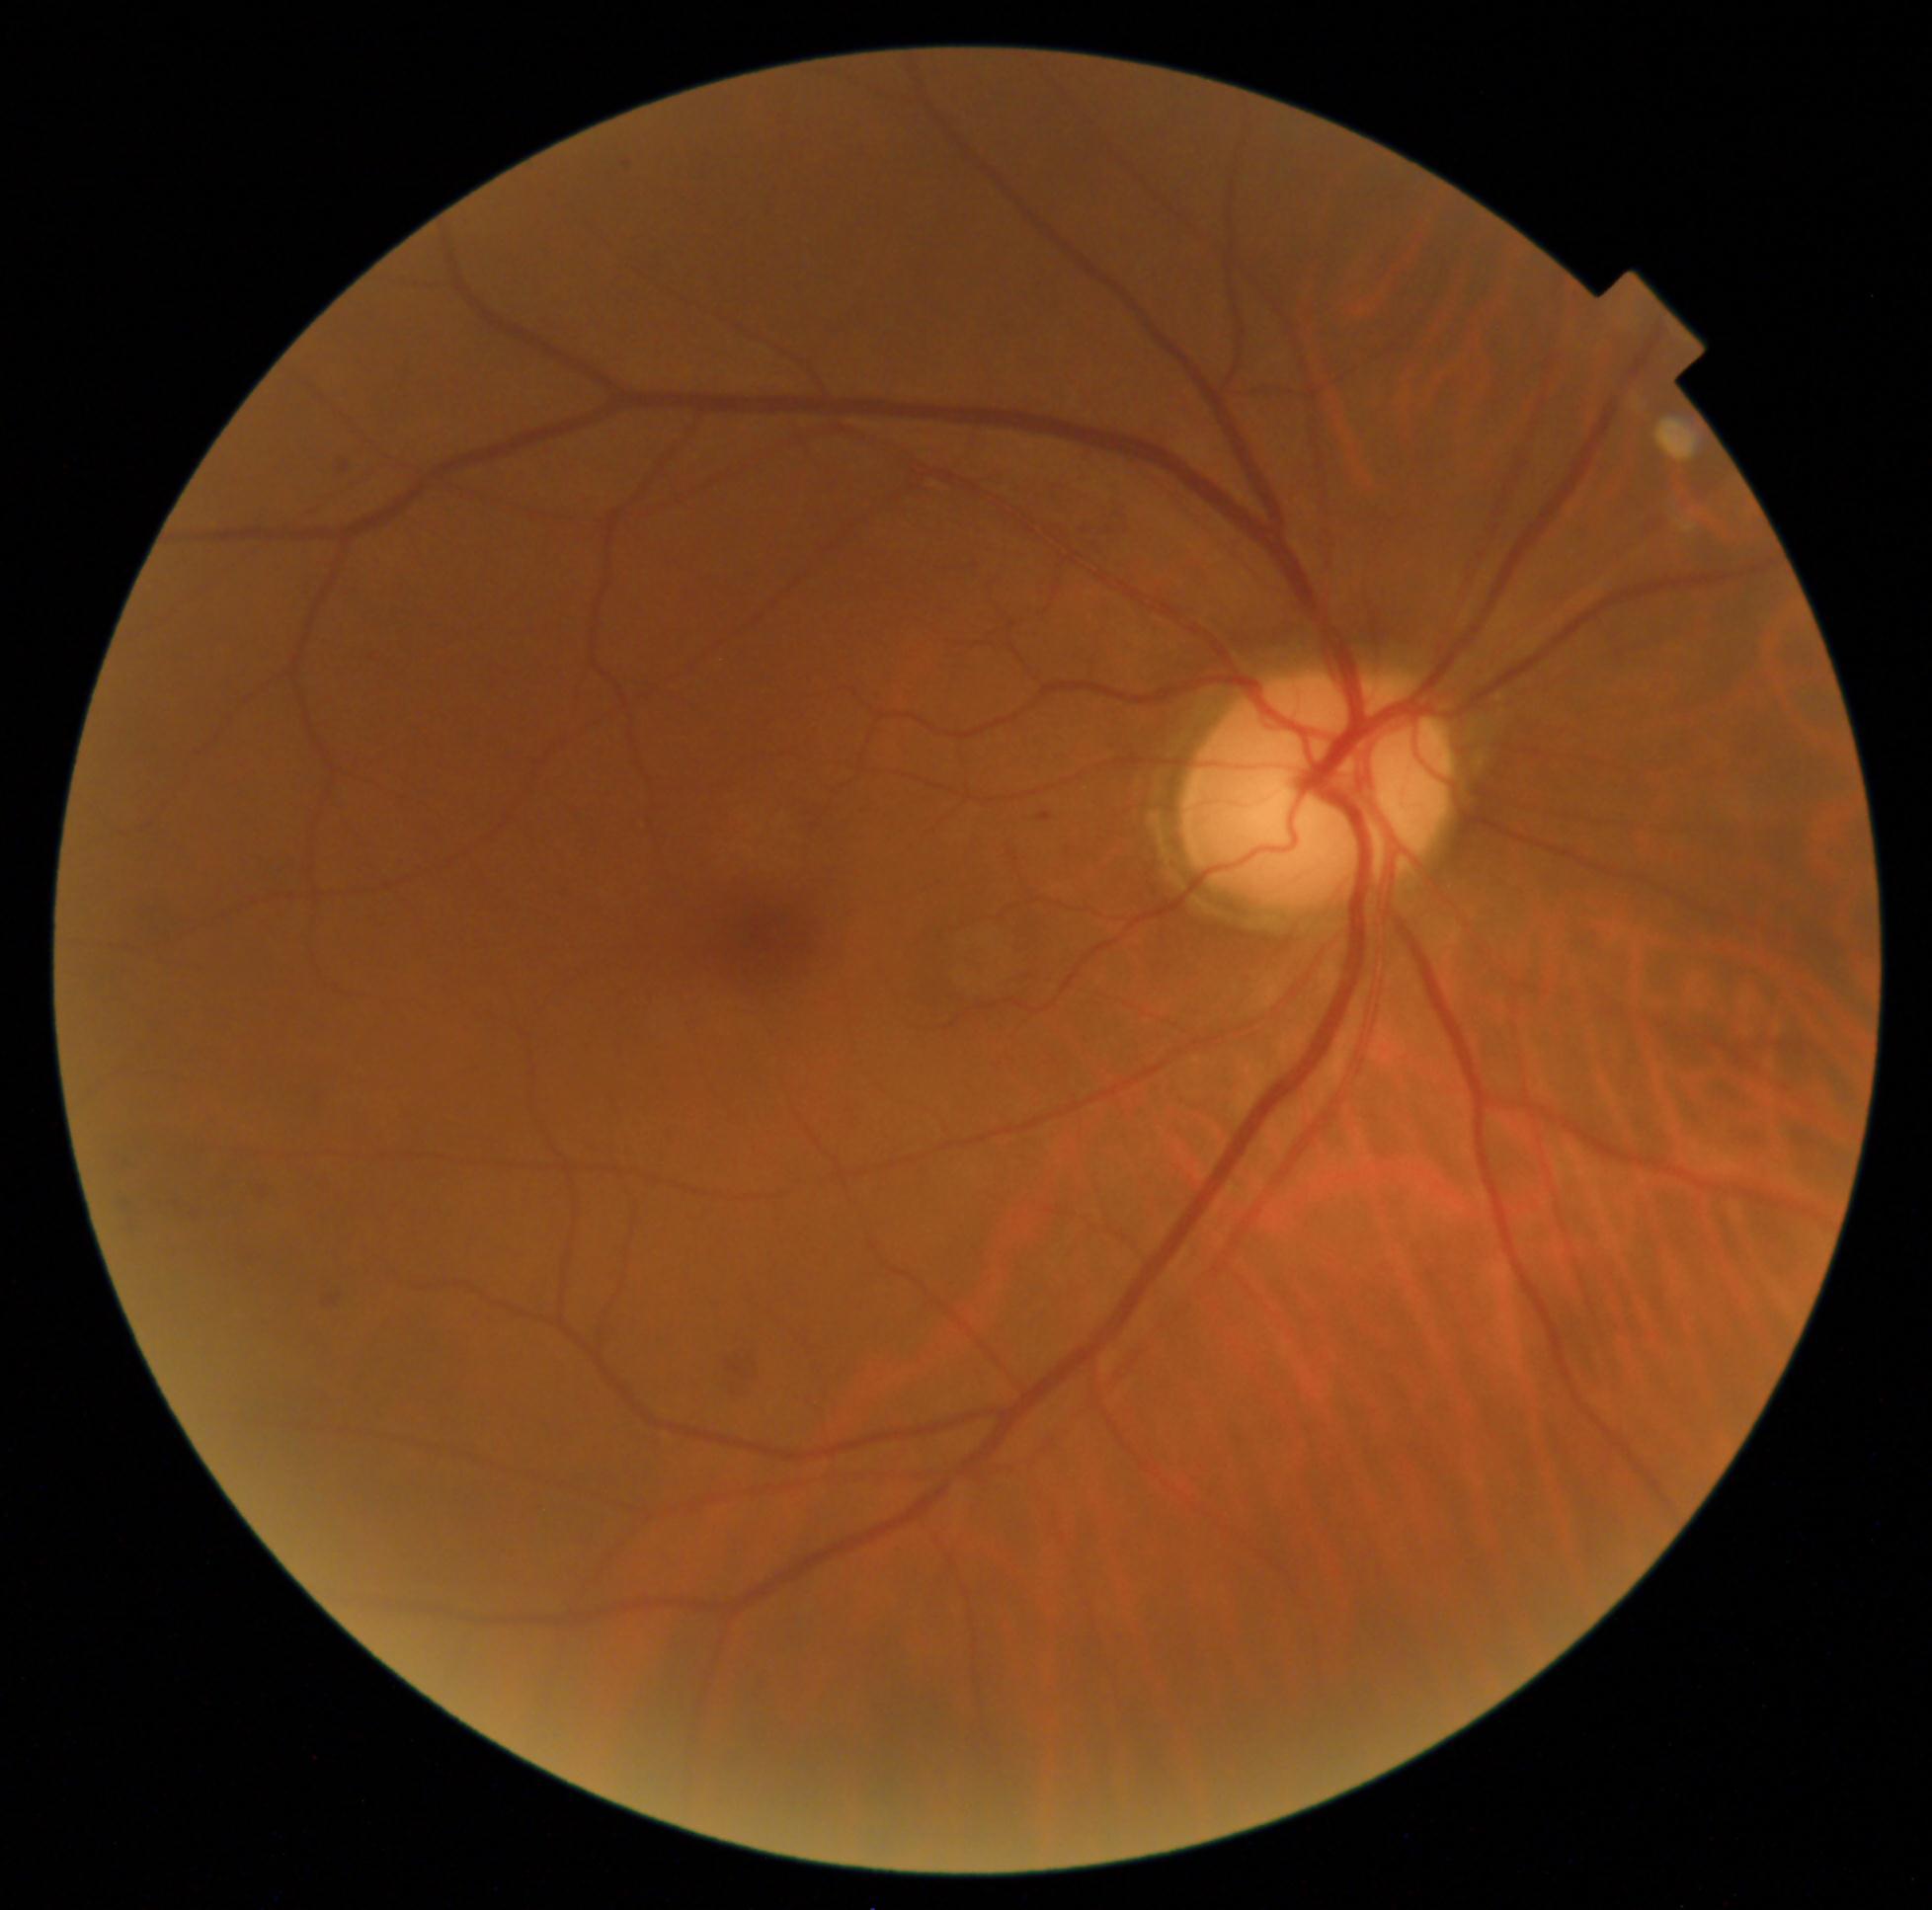 DR grade = 2 — more than just microaneurysms but less than severe NPDR